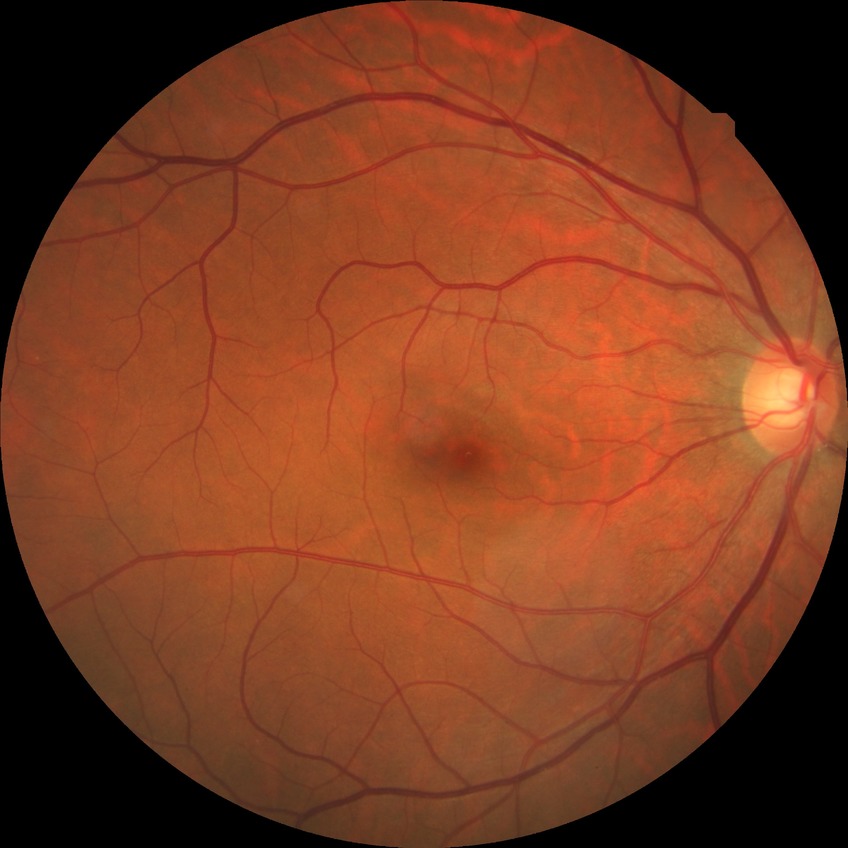

Assessment:
• diabetic retinopathy (DR) — no diabetic retinopathy (NDR)